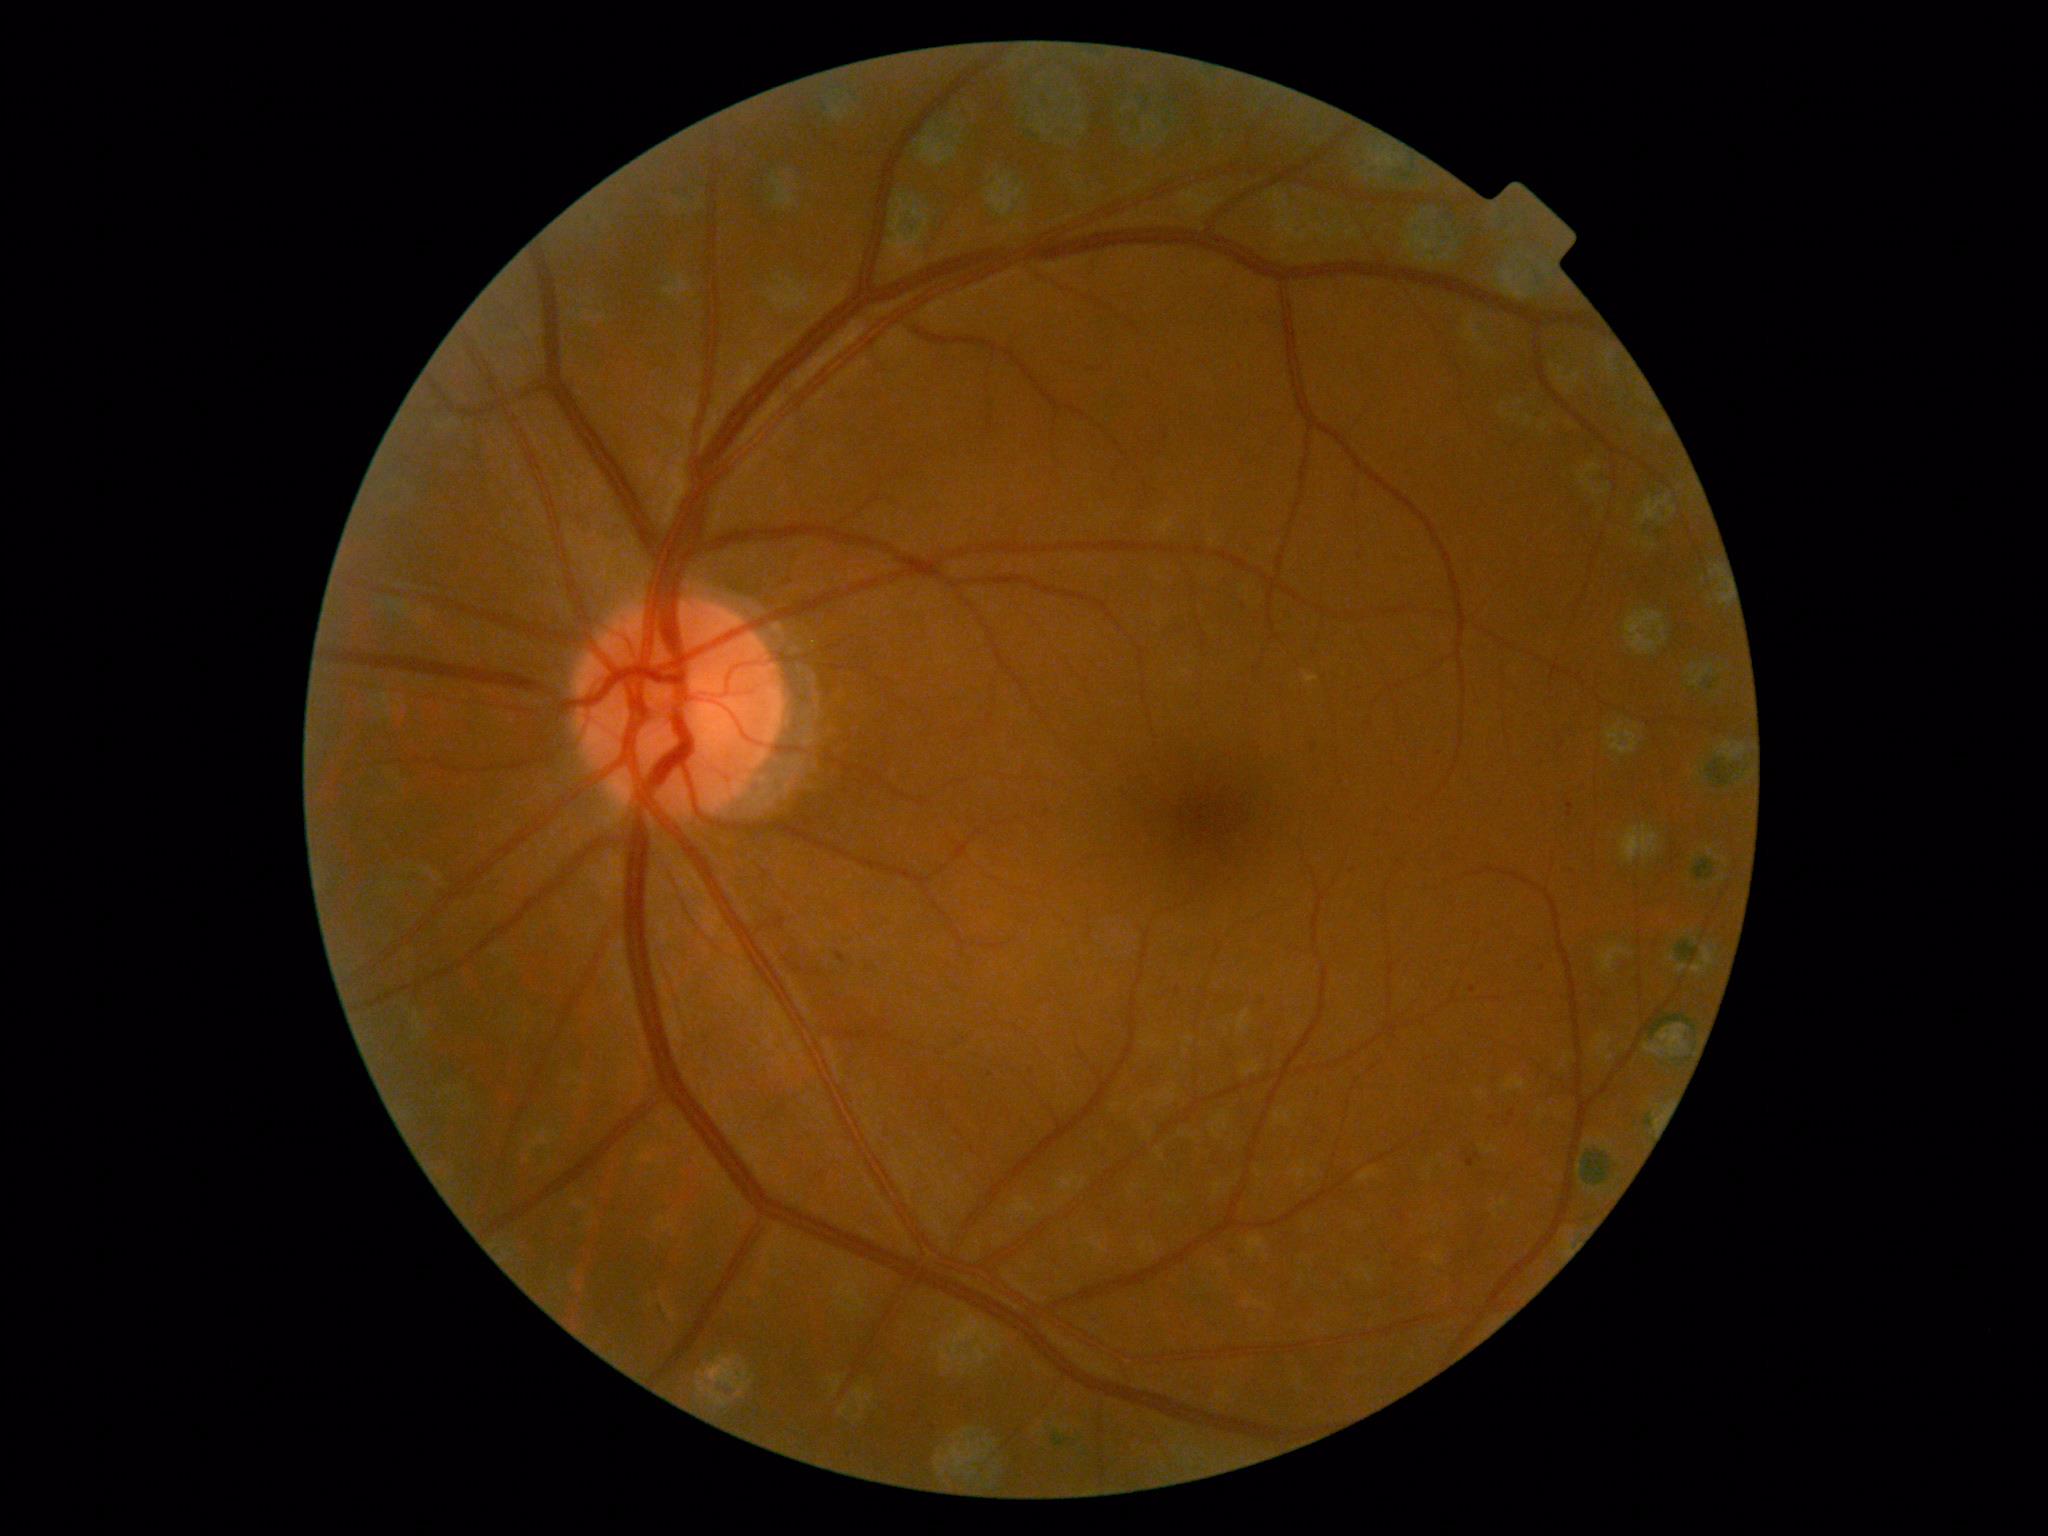 Disease class: non-proliferative diabetic retinopathy. DR grade is 2.